Infant wide-field fundus photograph — 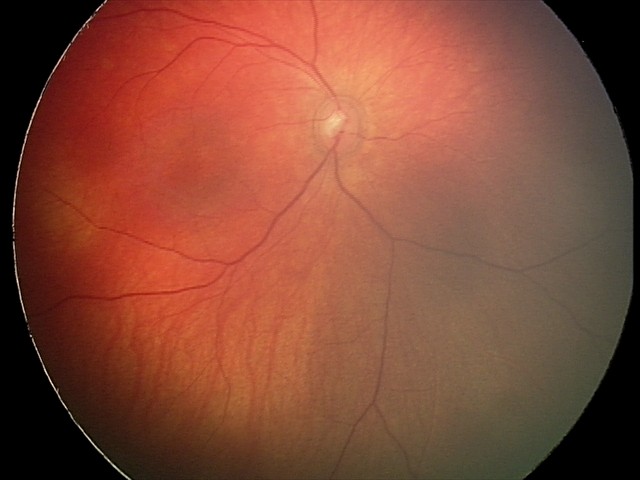

Screening examination consistent with retinal hemorrhages.